Image size 848x848. Camera: NIDEK AFC-230. Posterior pole color fundus photograph. Davis DR grading — 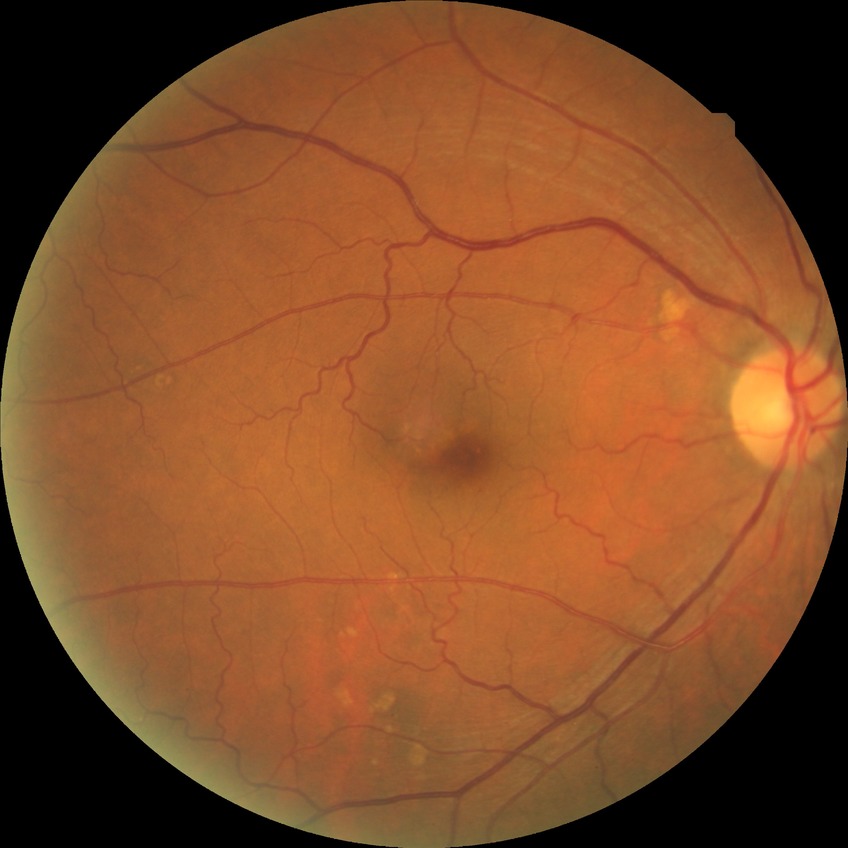 Diabetic retinopathy (DR) is no diabetic retinopathy (NDR).